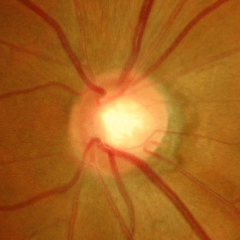

Glaucoma status = advanced glaucomatous optic neuropathy.